45° FOV; fundus photo:
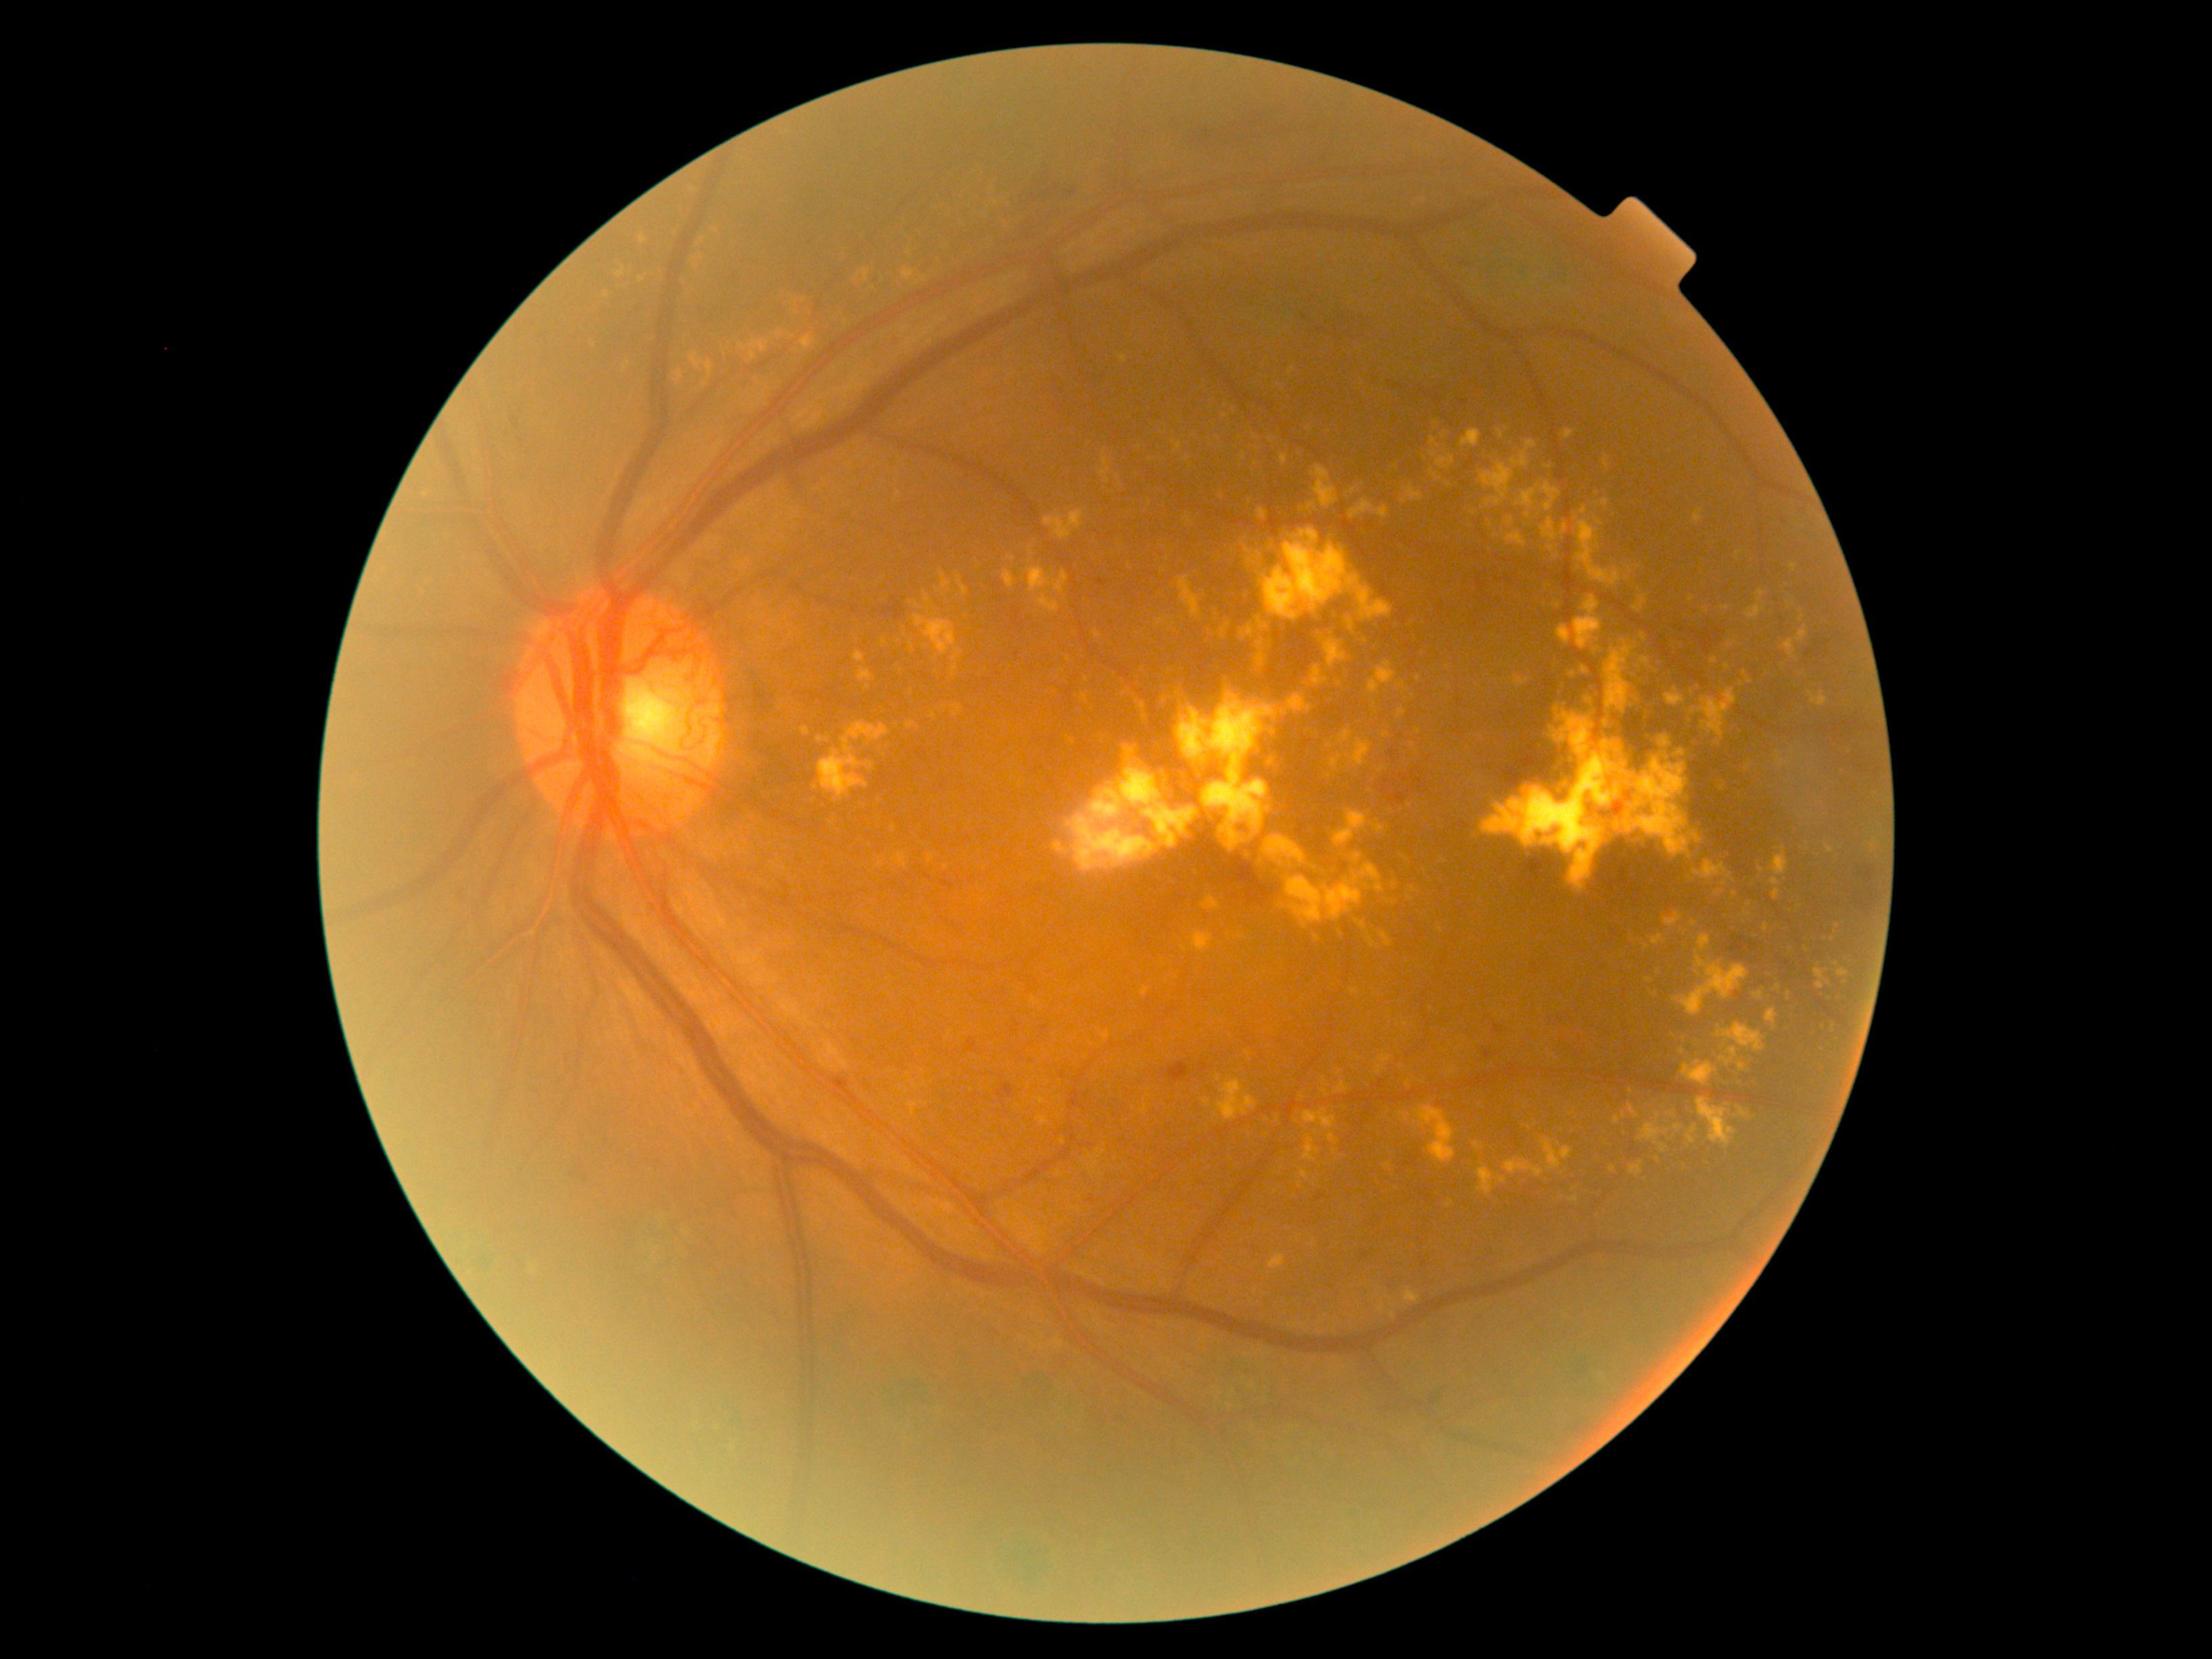 partial: true
dr_grade: 4
dr_grade_name: PDR
lesions:
  ex:
    - bbox=[1677, 752, 1685, 757]
    - bbox=[1177, 577, 1200, 620]
    - bbox=[1540, 518, 1559, 543]
    - bbox=[1604, 642, 1639, 712]
    - bbox=[1809, 692, 1828, 707]
    - bbox=[1563, 430, 1574, 441]
    - bbox=[703, 360, 714, 379]
    - bbox=[1288, 865, 1295, 875]
    - bbox=[1660, 735, 1672, 747]
    - bbox=[1719, 783, 1726, 791]
    - bbox=[1820, 993, 1829, 1001]
    - bbox=[1738, 1062, 1748, 1071]
  ex_small_approx:
    - <pt>1324,1091</pt>
    - <pt>1702,1165</pt>
    - <pt>1280,385</pt>
    - <pt>1019,785</pt>
    - <pt>1591,811</pt>
    - <pt>1219,439</pt>
    - <pt>1695,923</pt>
    - <pt>1600,523</pt>